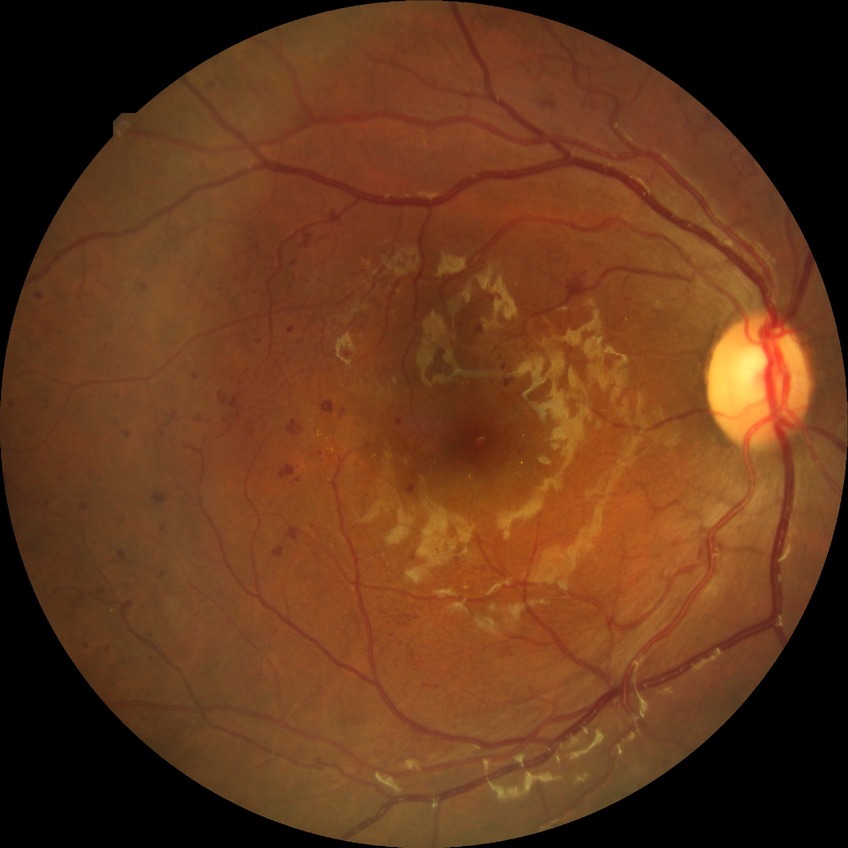

diabetic retinopathy (DR) = PDR (proliferative diabetic retinopathy)